Modified Davis classification
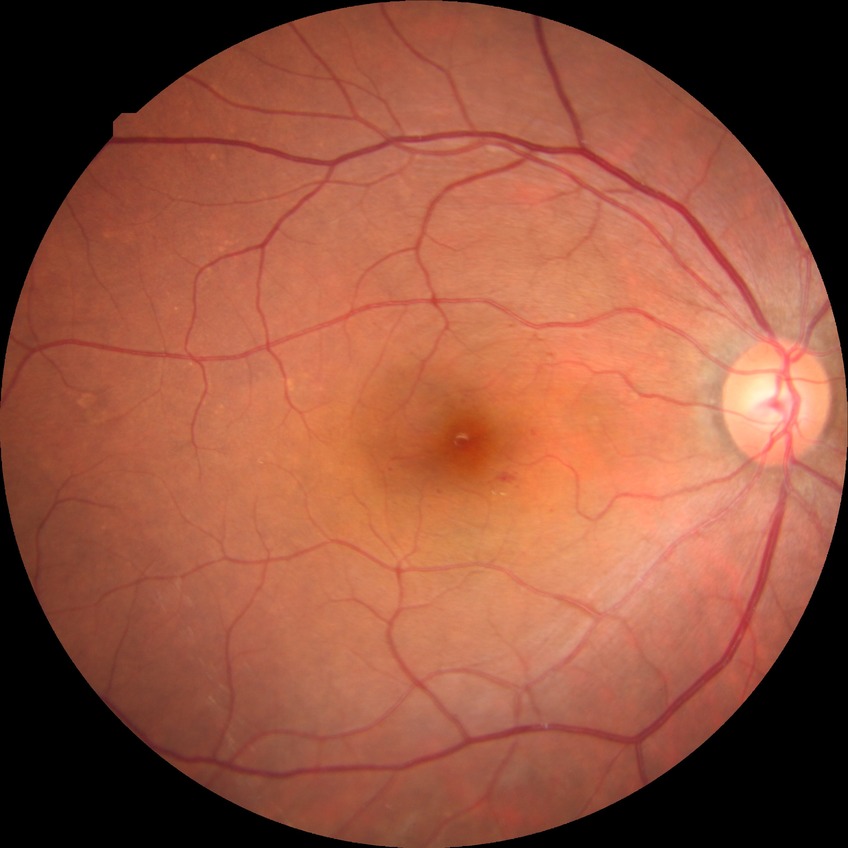   proliferative_class: non-proliferative diabetic retinopathy
  davis_grade: simple diabetic retinopathy (SDR)